45-degree field of view:
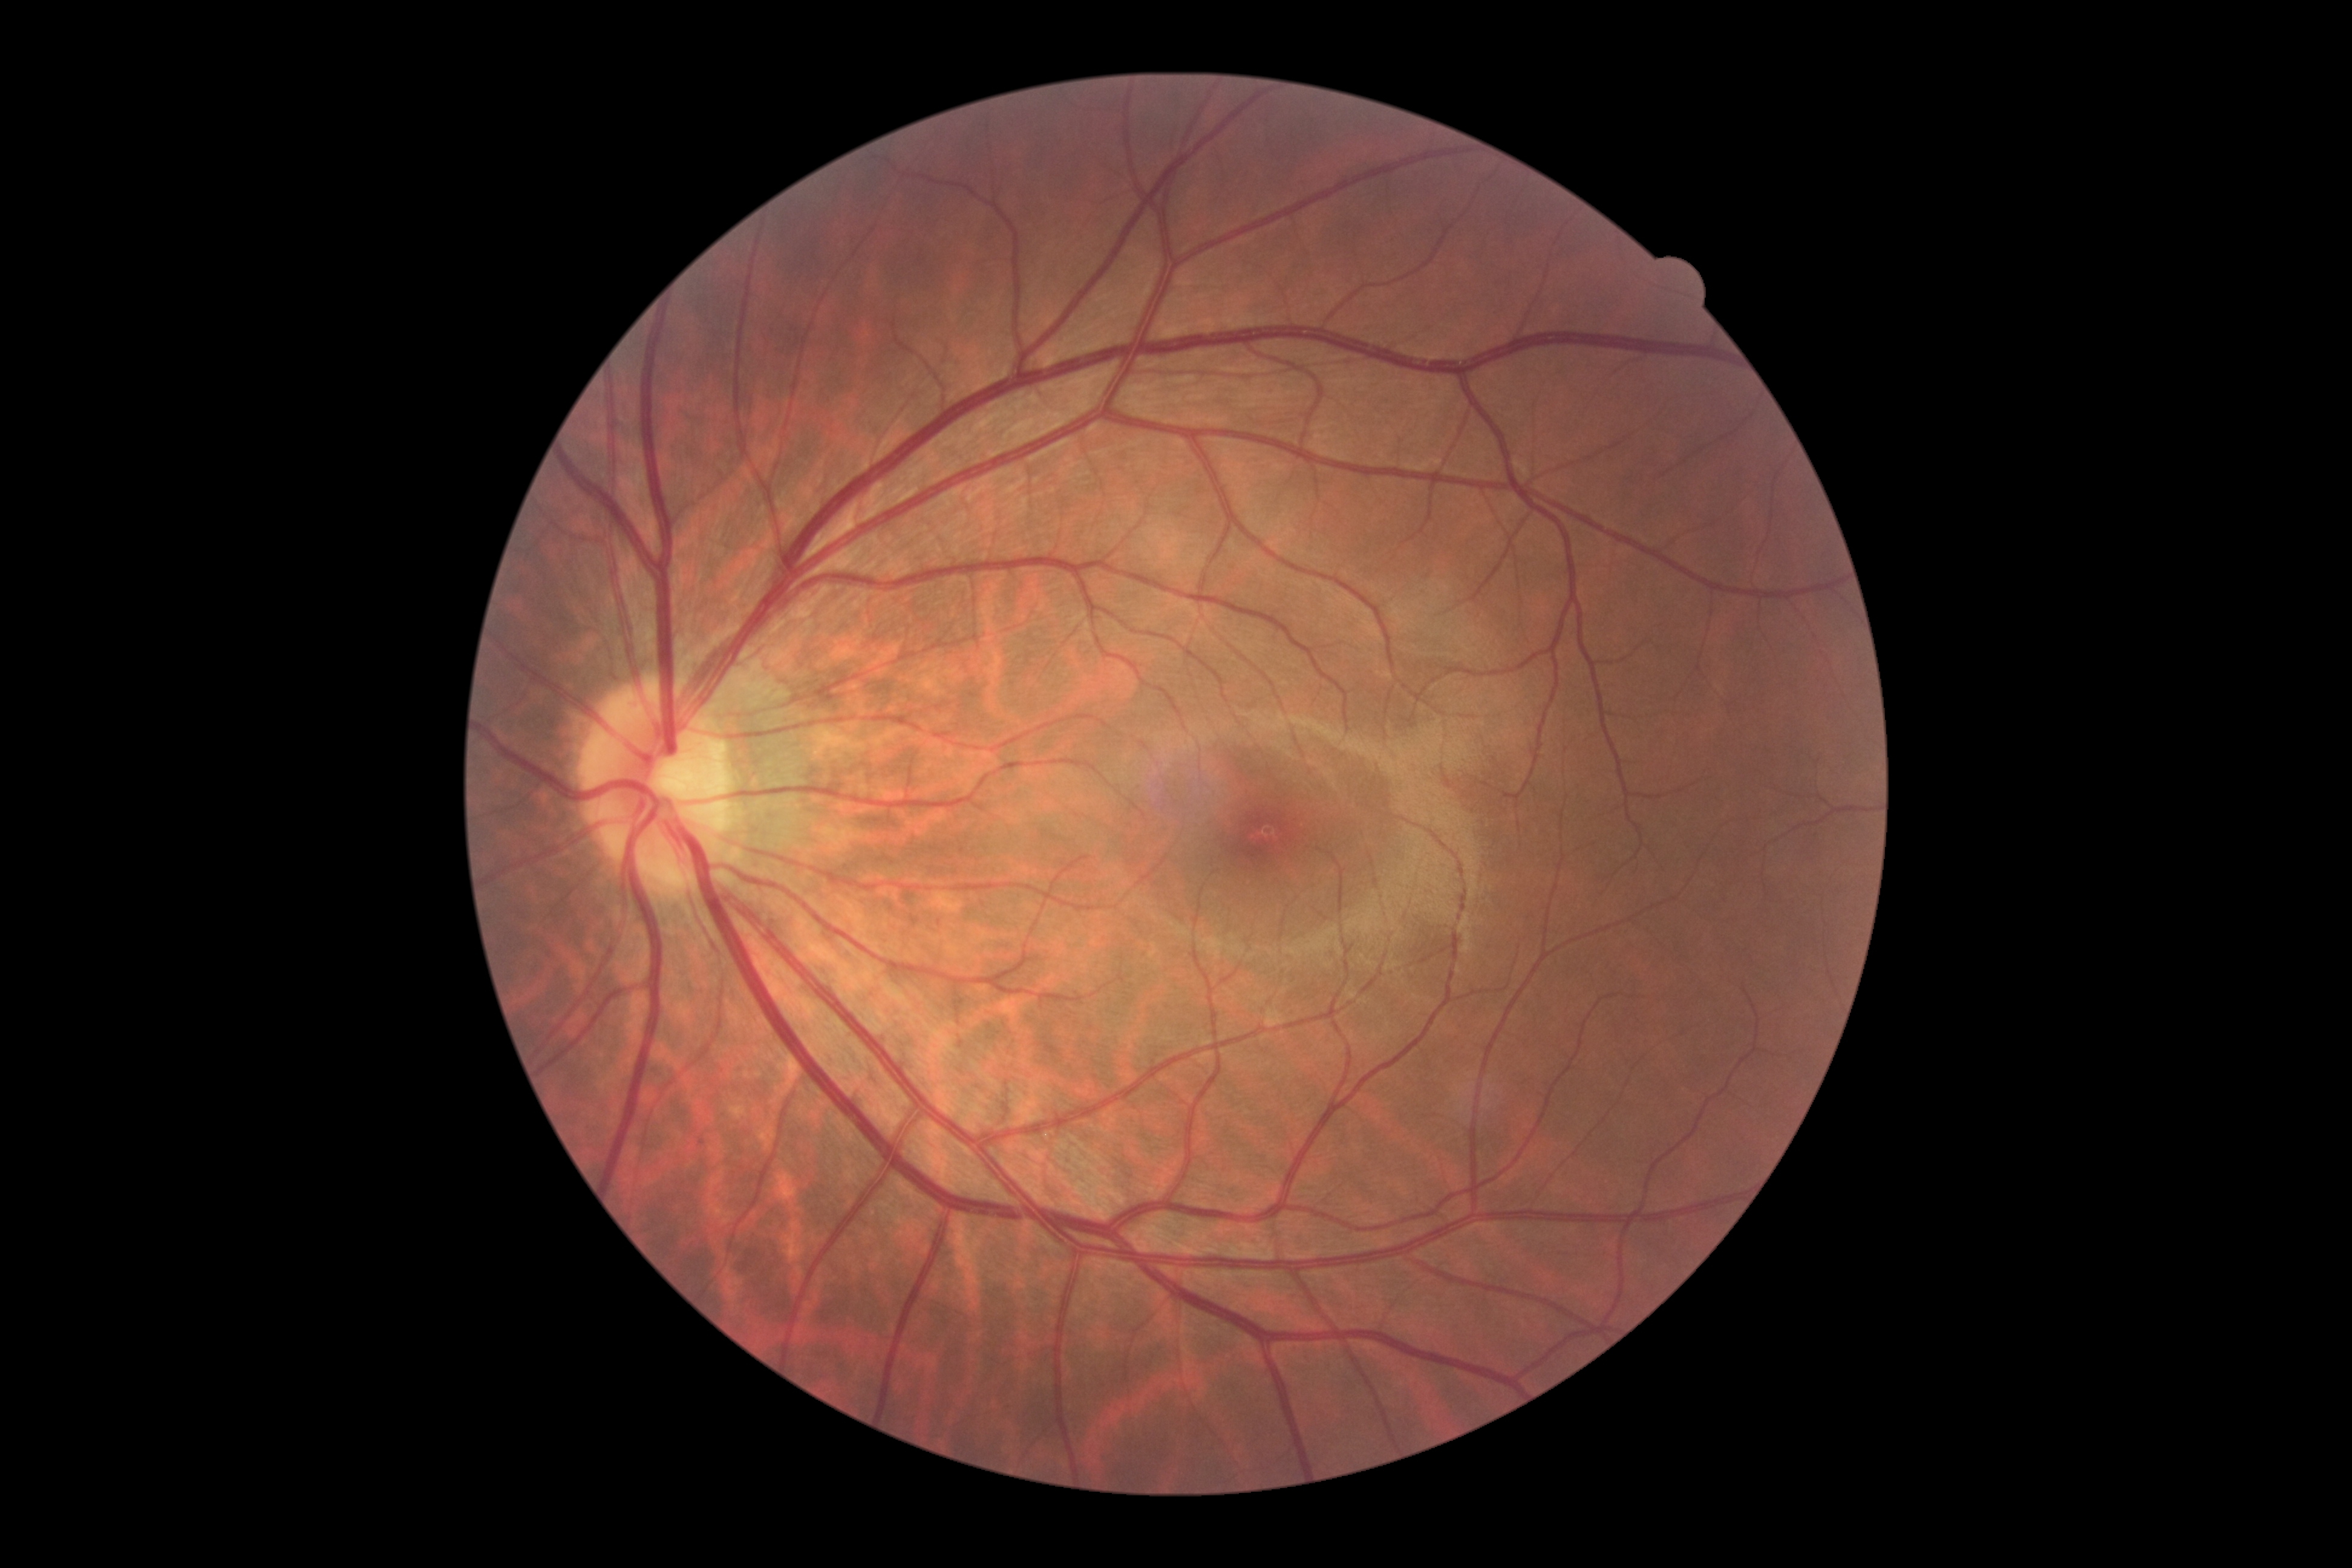

Diabetic retinopathy (DR): 0 — no visible signs of diabetic retinopathy.
No signs of diabetic retinopathy.